45° FOV · 2352x1568px
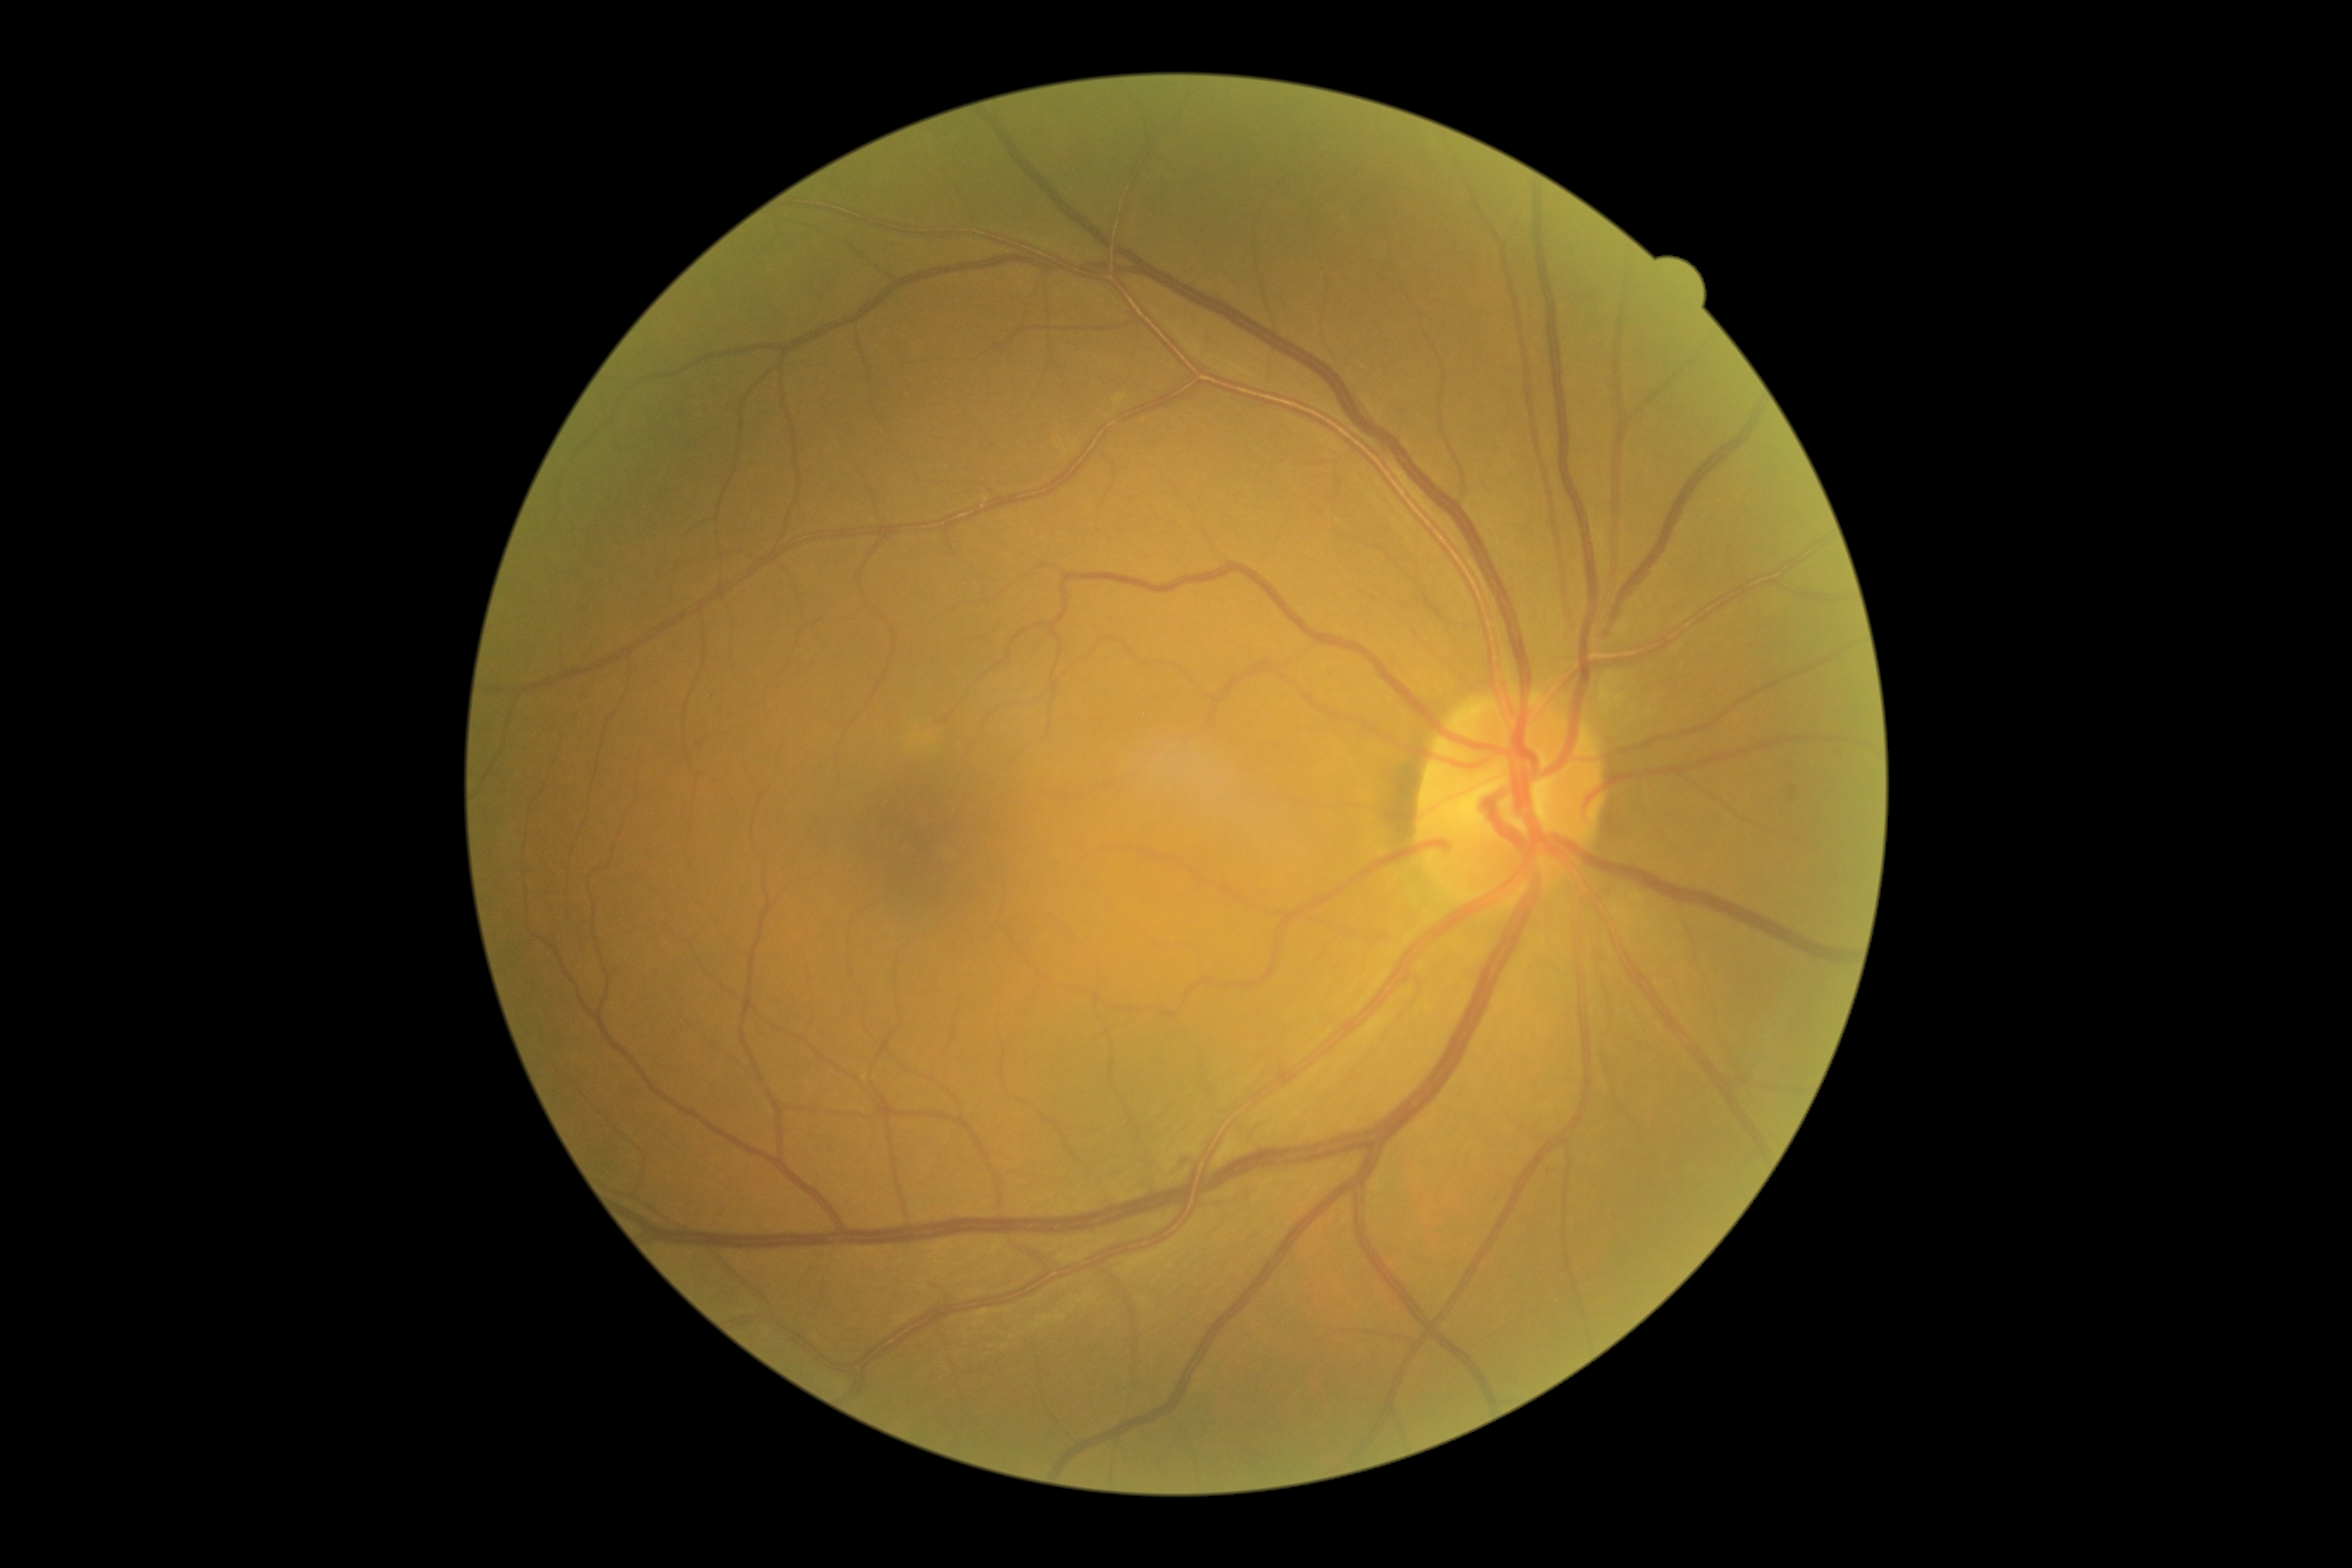 Retinopathy grade is mild NPDR (1).